FOV: 45 degrees:
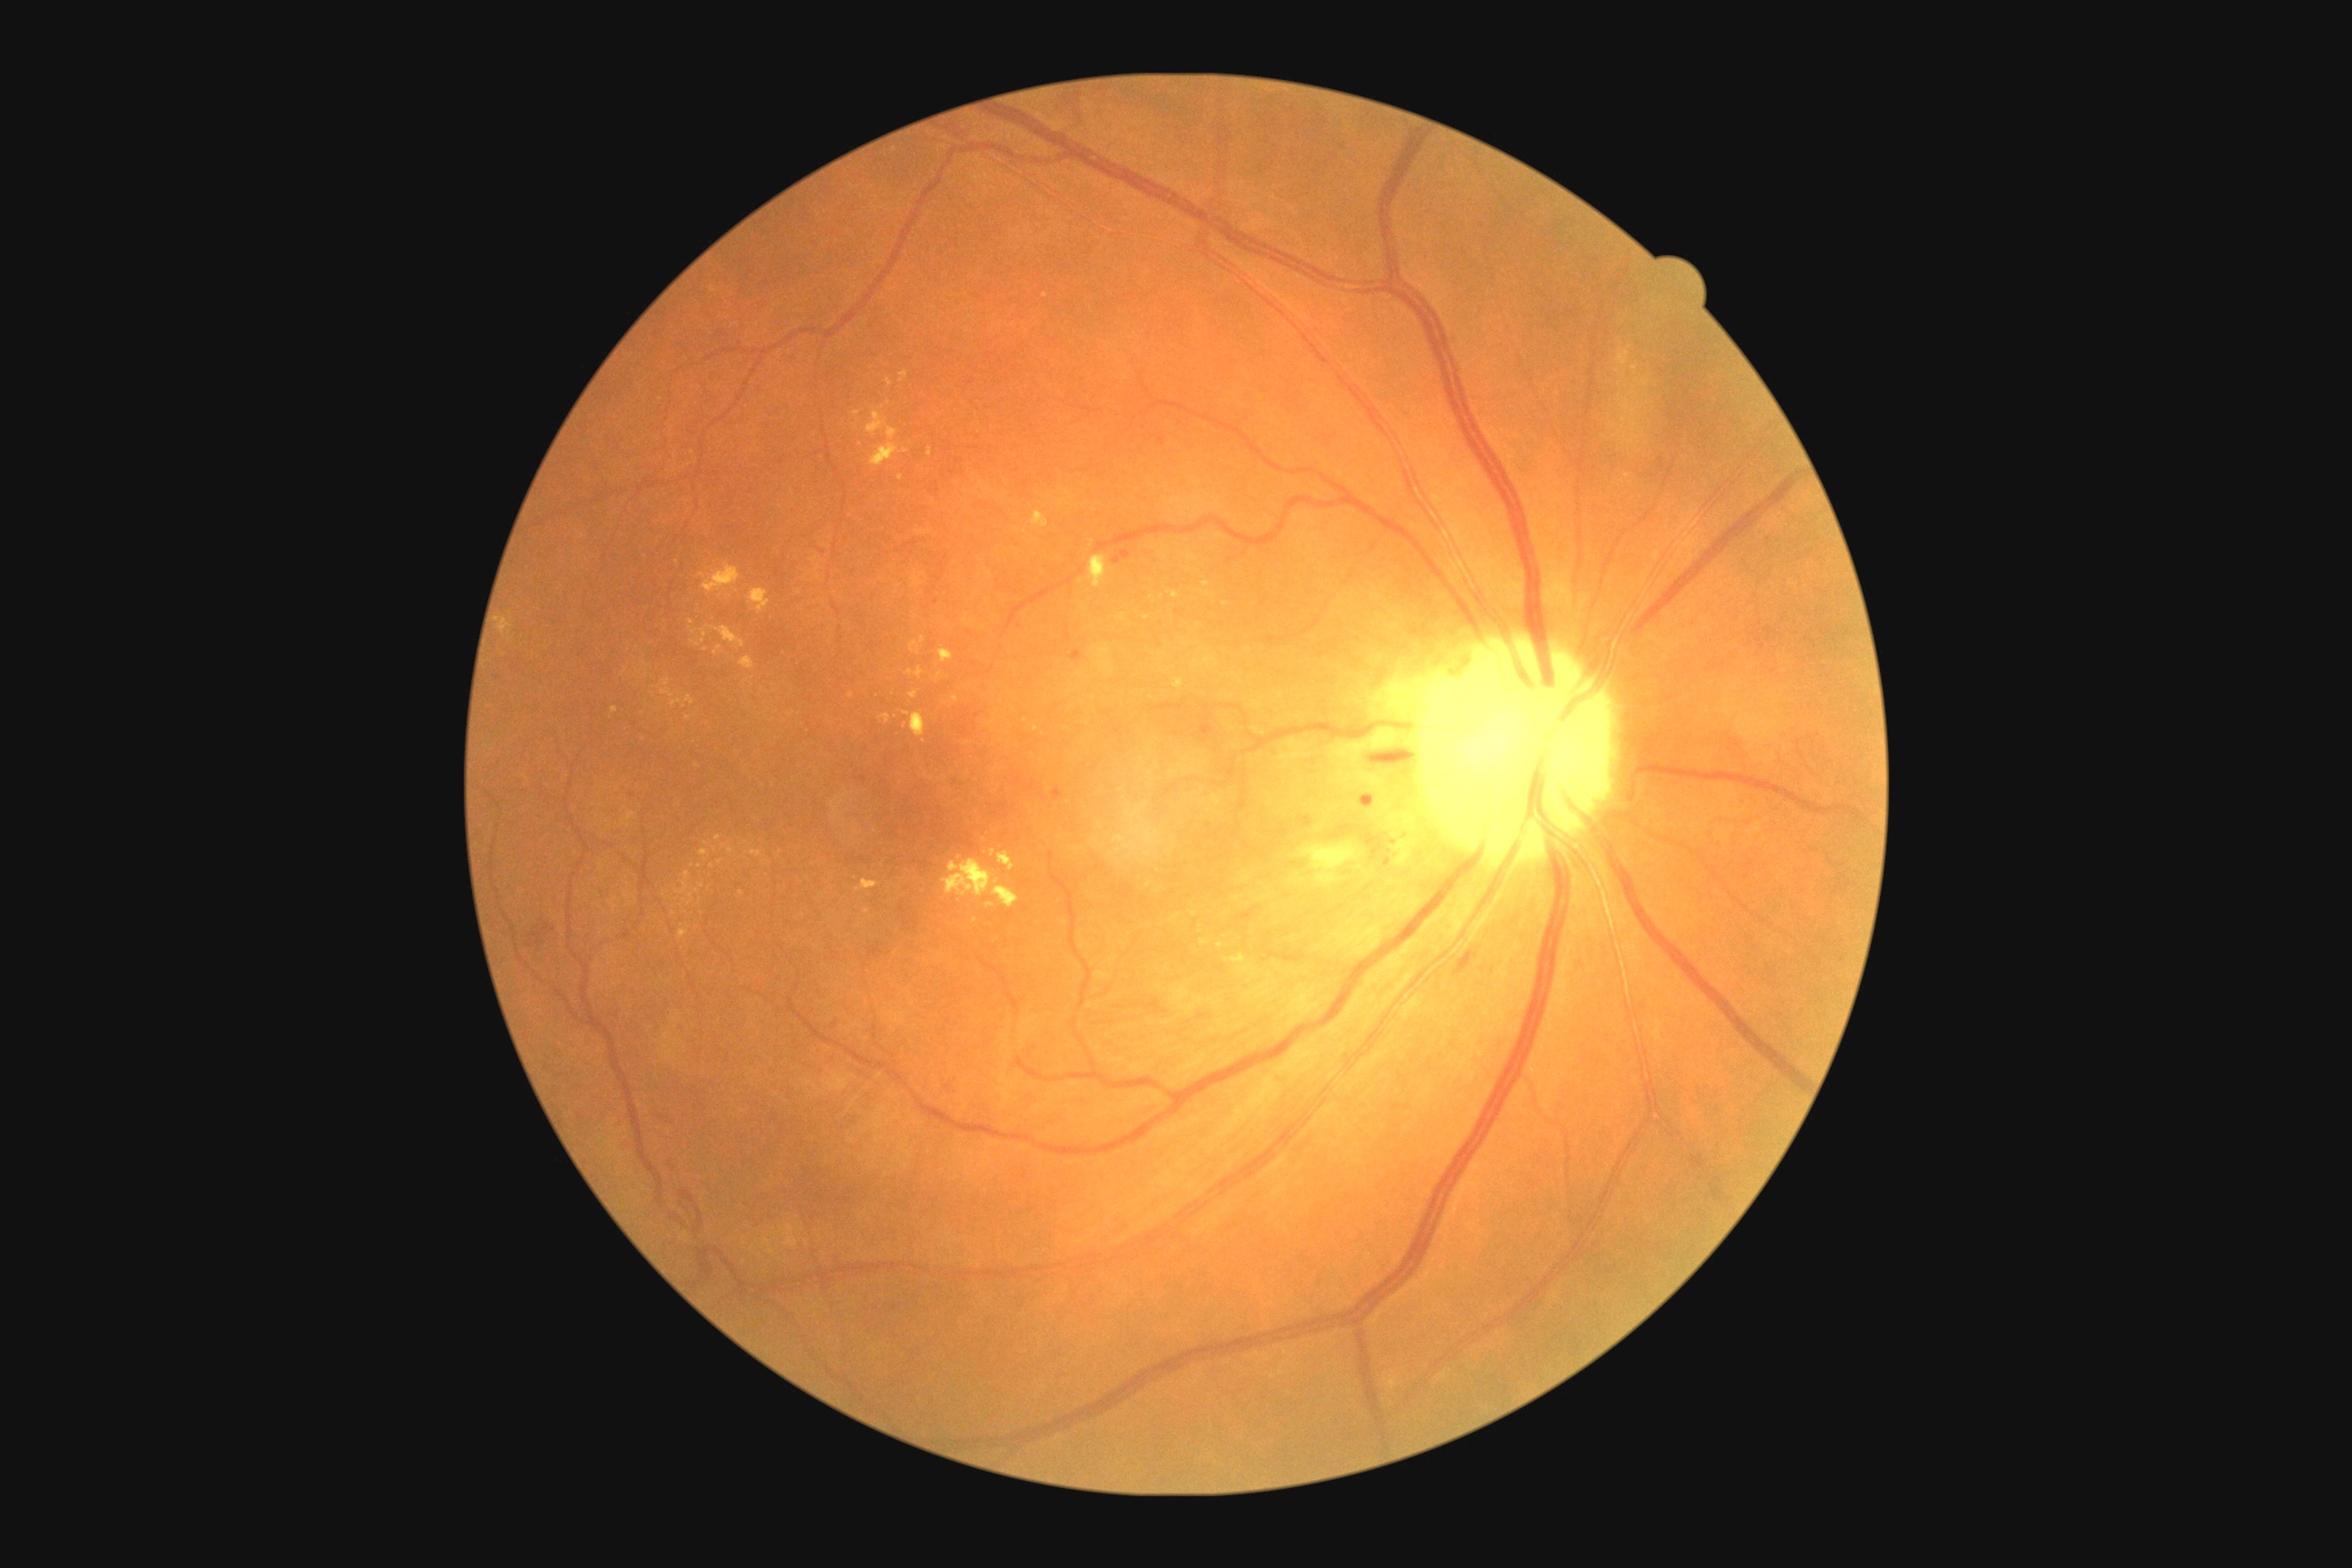
Retinopathy grade: 2 — more than just microaneurysms but less than severe NPDR
Selected lesions:
hard exudates (continued) = box(997, 852, 1015, 872) | box(689, 894, 694, 905) | box(939, 649, 954, 663) | box(1088, 554, 1112, 589) | box(701, 629, 709, 643) | box(714, 645, 723, 656) | box(910, 642, 921, 654) | box(691, 640, 700, 647) | box(1121, 614, 1126, 622)
Small hard exudates near 742, 894 | 1151, 598 | 955, 699 | 615, 710 | 698, 892 | 724, 846 | 649, 667 | 906, 714 | 1129, 805 | 888, 404